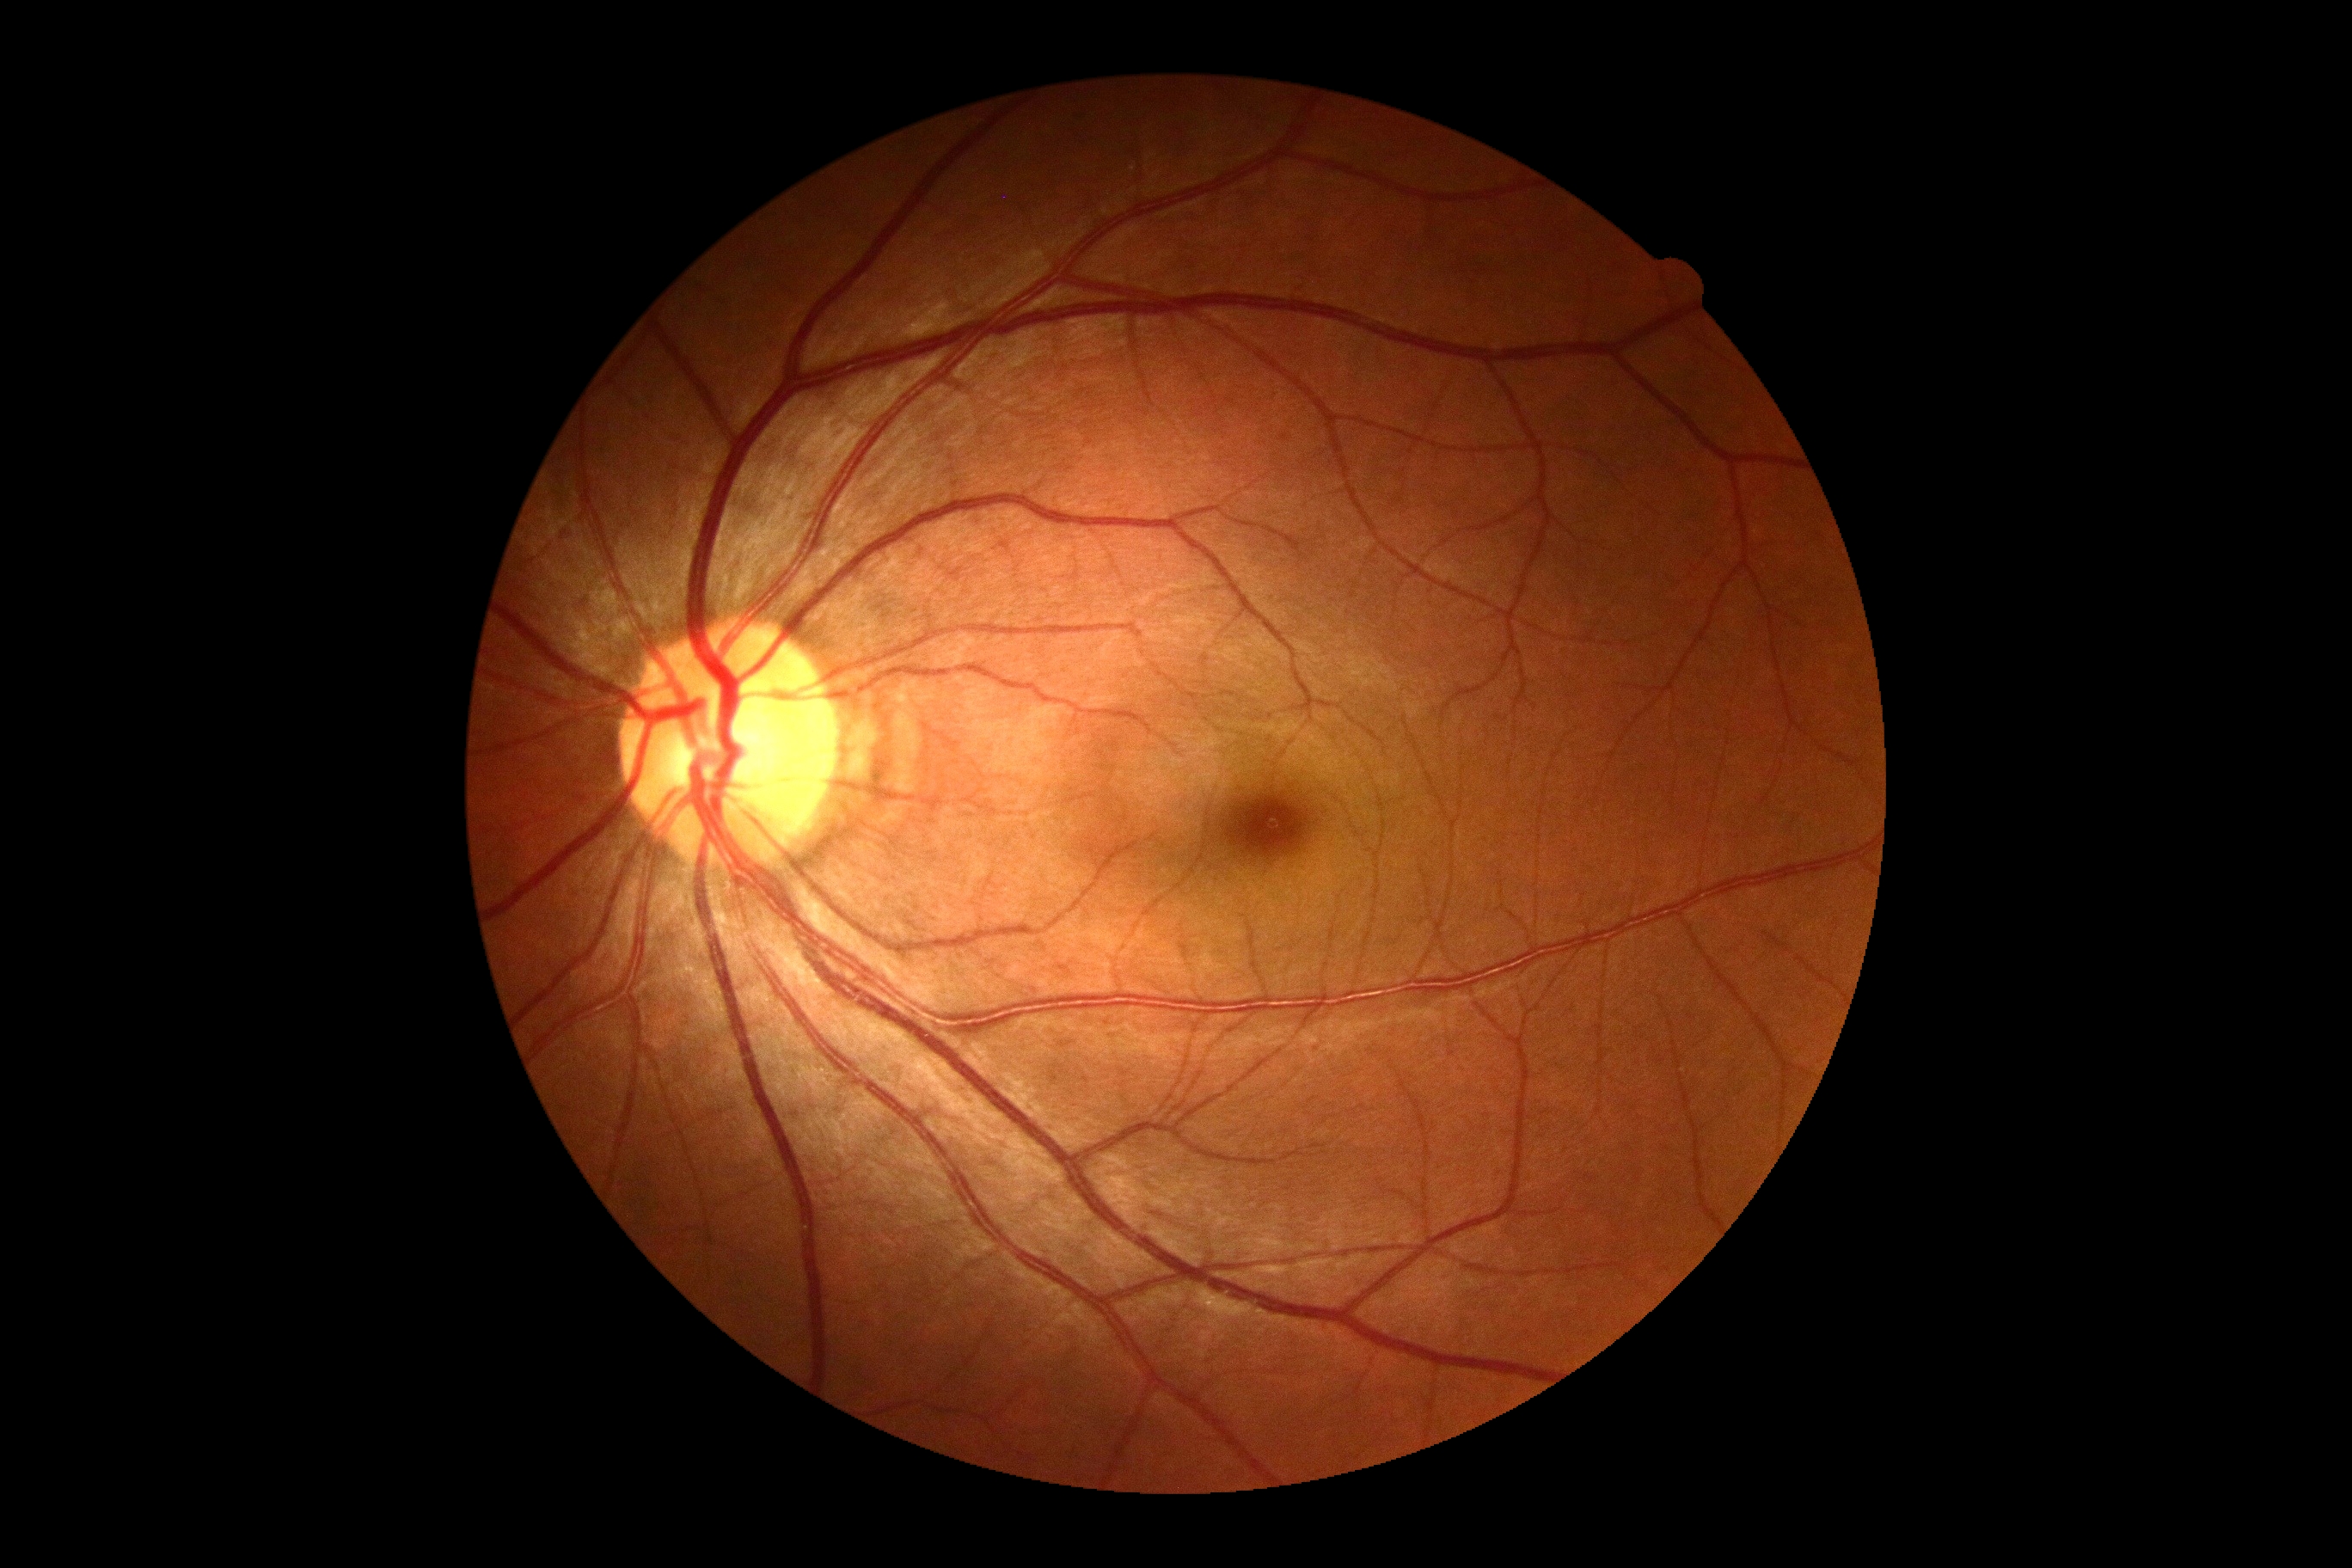   dr_impression: no apparent DR
  dr_grade: 0/4